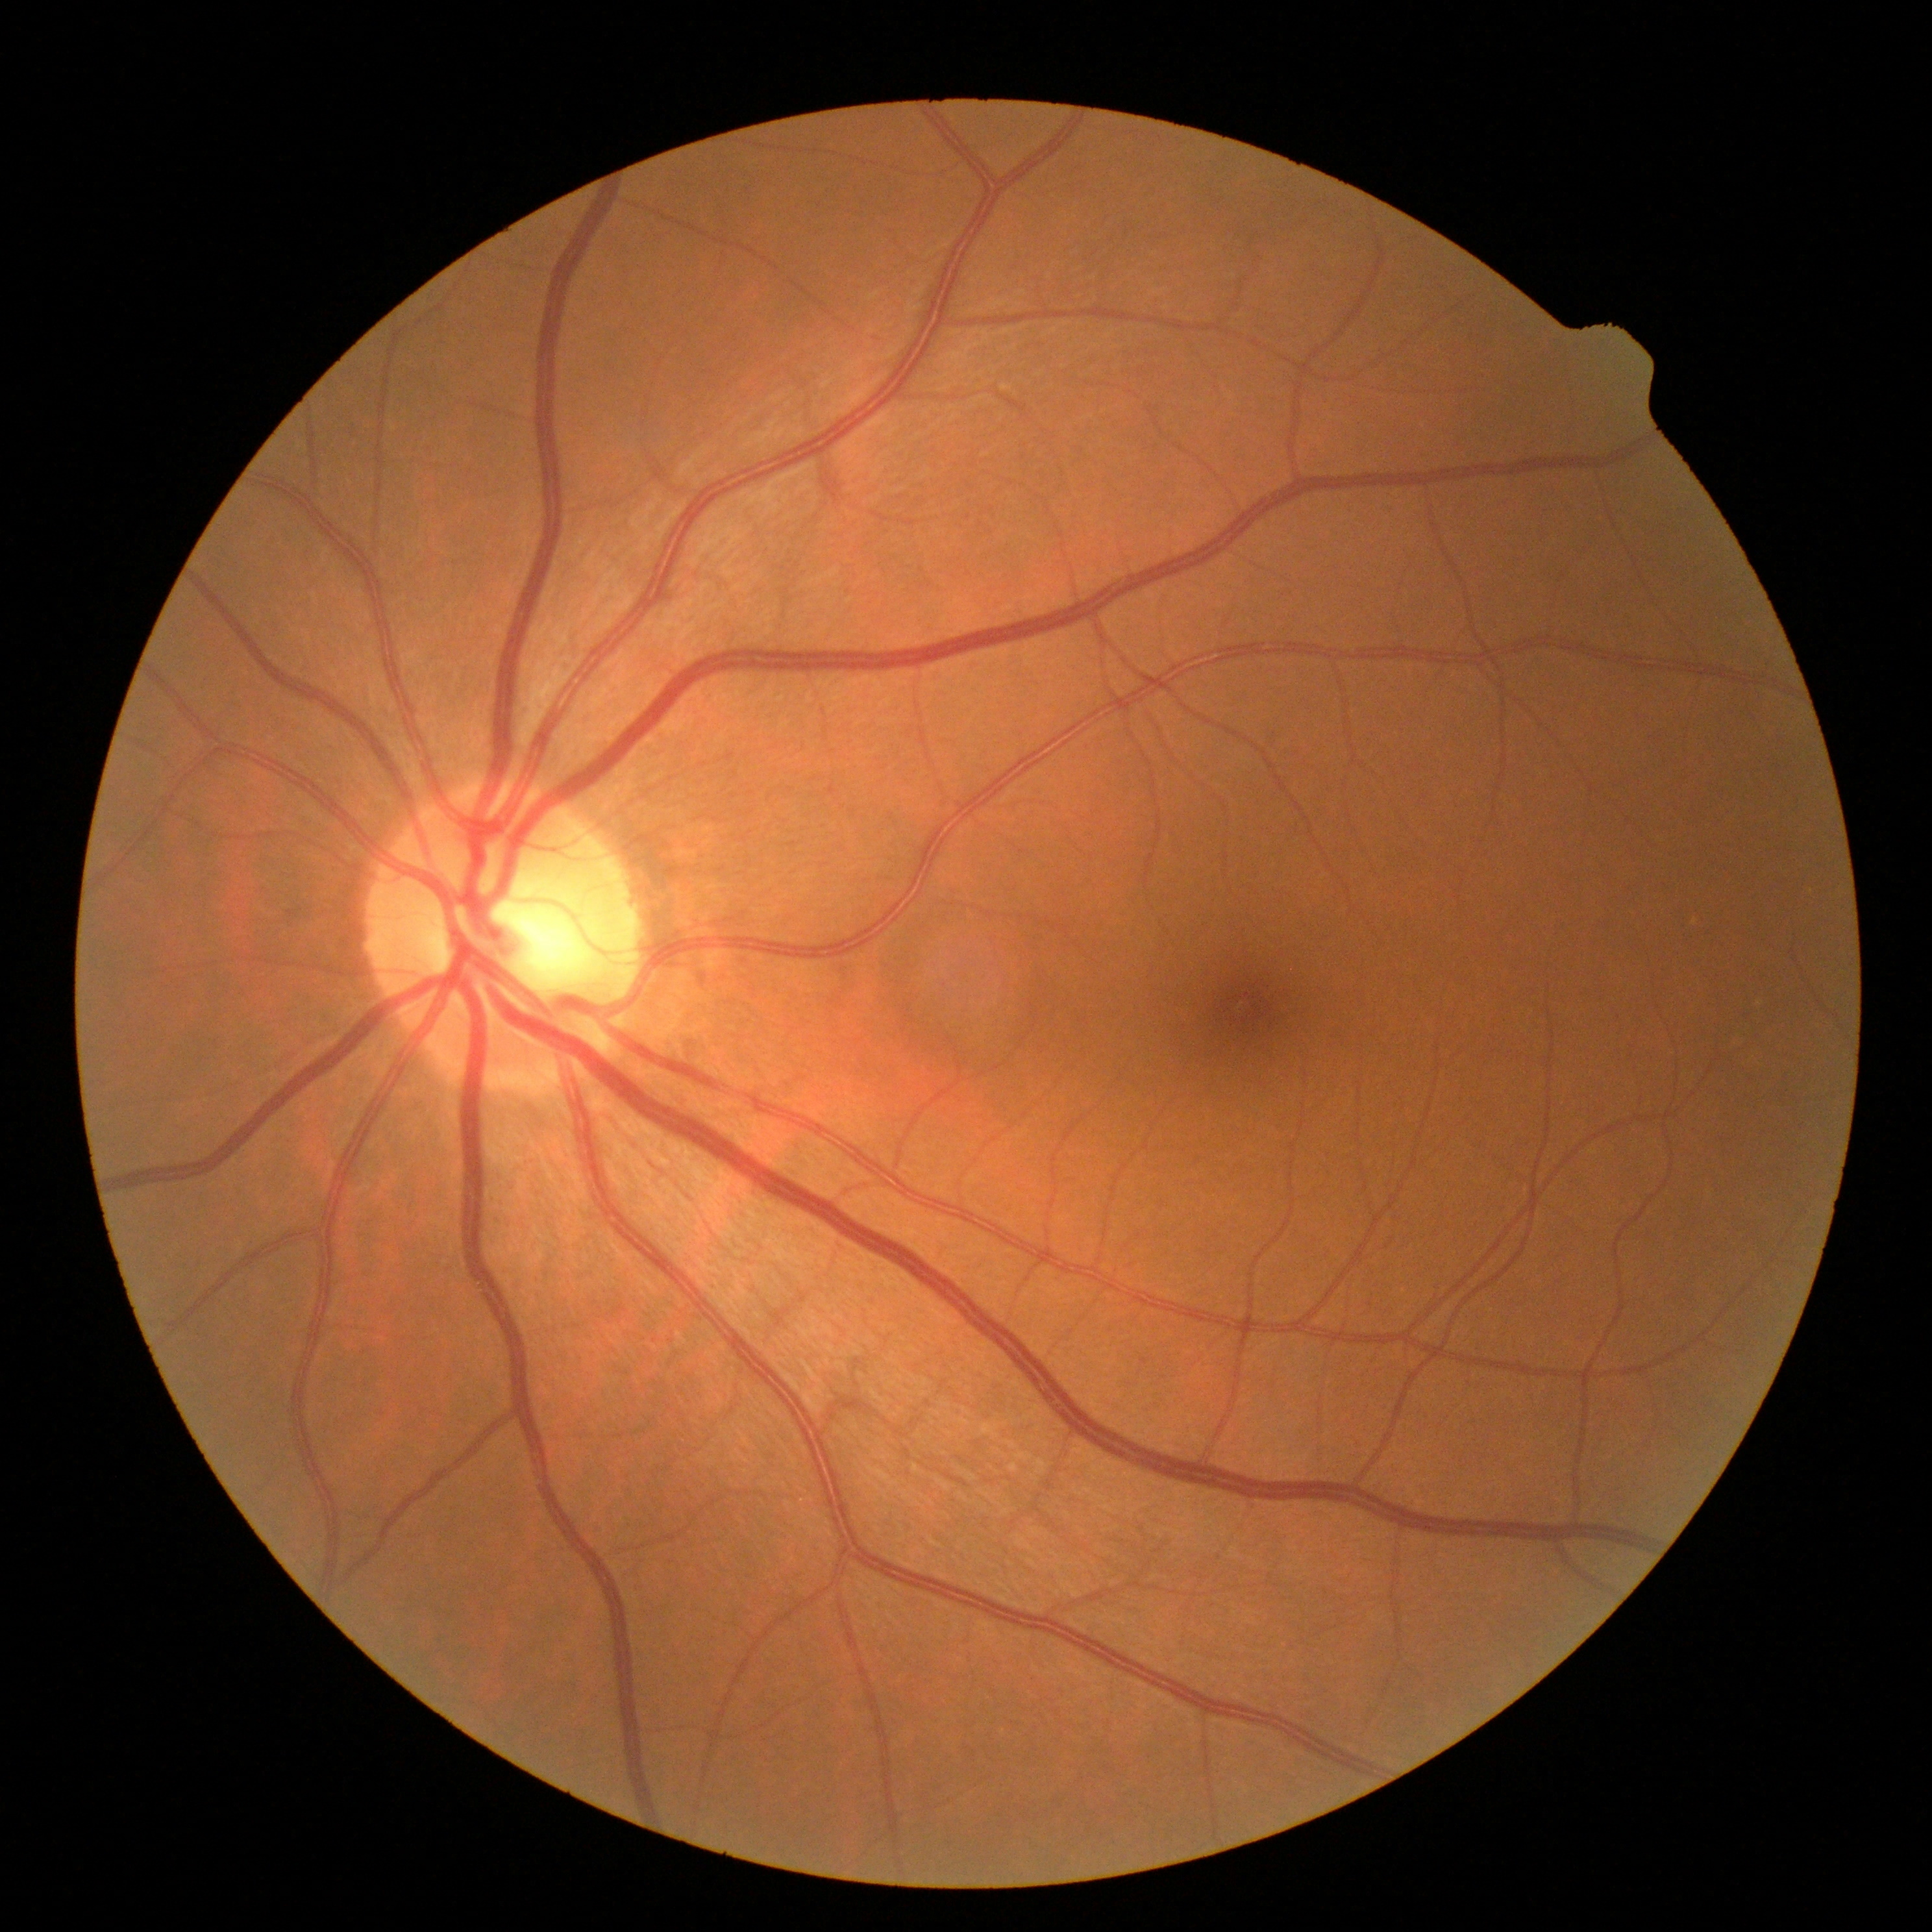 DR: no apparent retinopathy (grade 0).